45-degree field of view
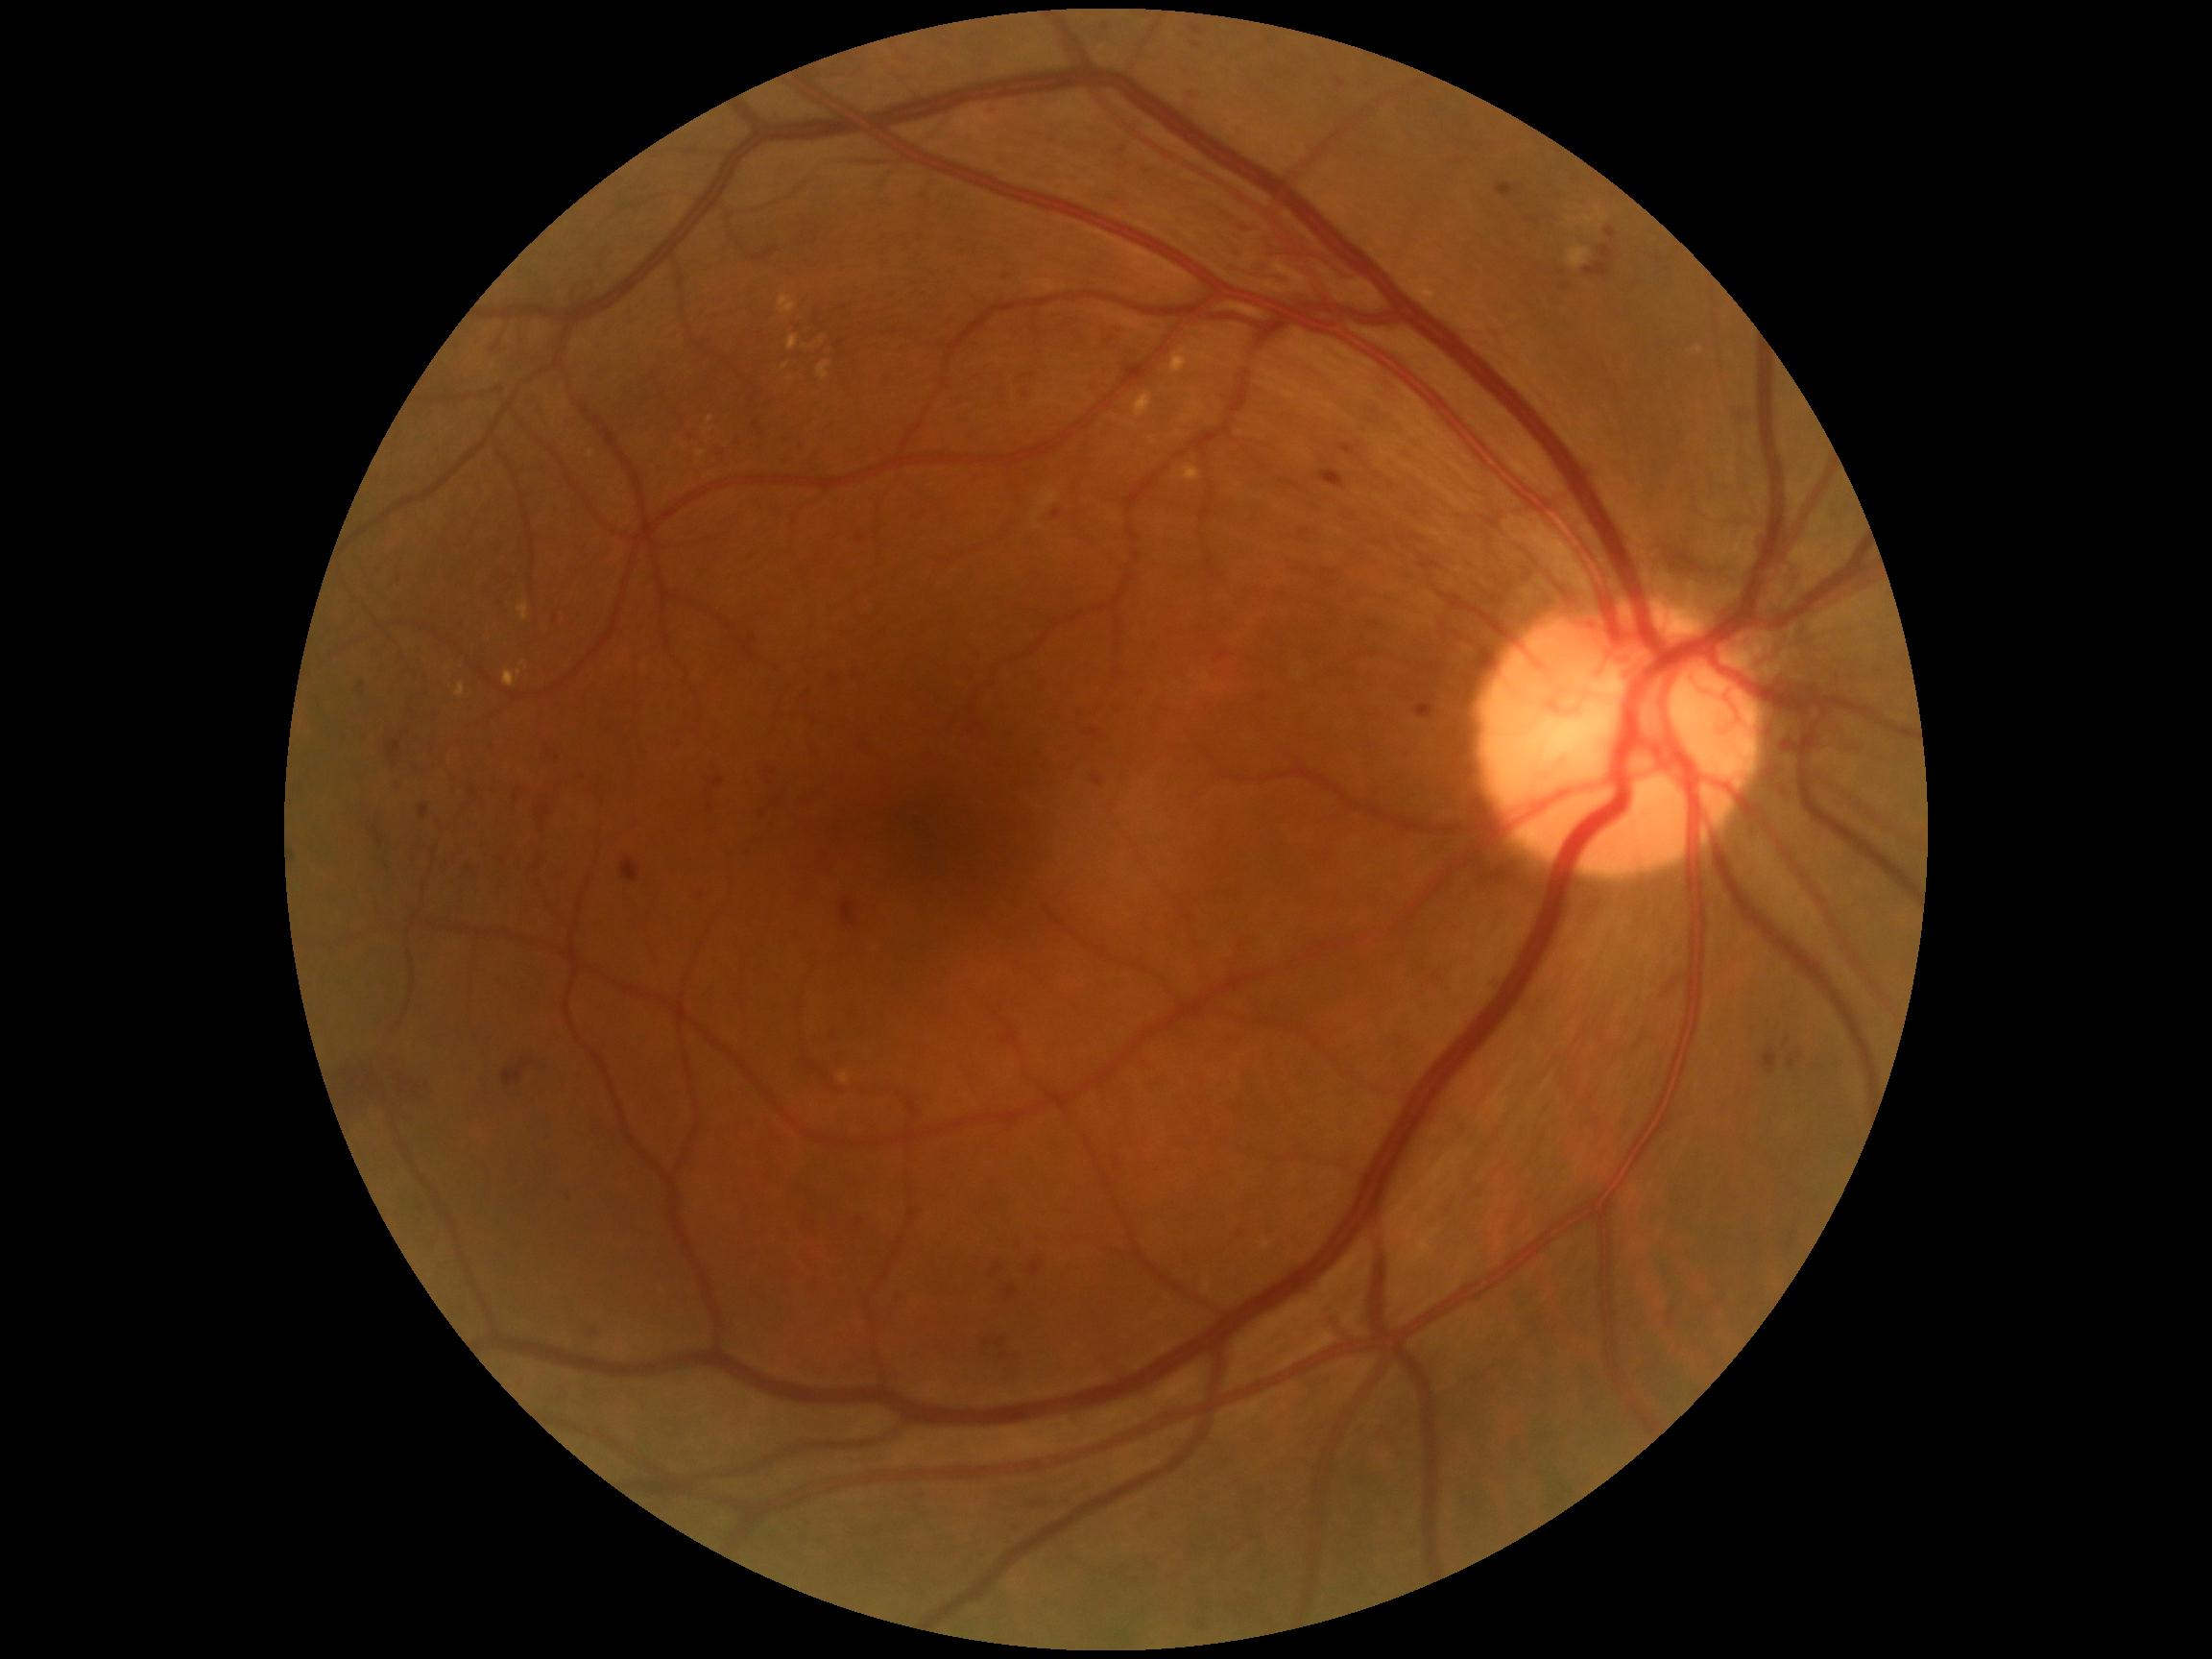

Retinopathy grade is 4/4
Lesions identified (partial list):
hard exudates (more not shown): Rect(1135, 393, 1152, 419) | Rect(1567, 247, 1591, 269) | Rect(455, 660, 464, 672) | Rect(788, 336, 799, 352) | Rect(455, 684, 465, 699) | Rect(445, 659, 450, 670) | Rect(589, 450, 595, 458) | Rect(1183, 467, 1201, 483) | Rect(504, 672, 517, 688)
Smaller hard exudates around (822; 342) | (1699; 351) | (520; 673) | (811; 347)
soft exudates: not present
hemorrhages (more not shown): Rect(1605, 227, 1617, 240) | Rect(1763, 1049, 1777, 1075) | Rect(780, 431, 791, 441) | Rect(1099, 324, 1125, 354) | Rect(987, 1260, 1001, 1281) | Rect(388, 741, 402, 768) | Rect(536, 781, 552, 825) | Rect(1032, 1264, 1040, 1276) | Rect(1008, 1288, 1018, 1298) | Rect(999, 1353, 1011, 1361) | Rect(330, 1057, 431, 1120) | Rect(1190, 26, 1204, 36) | Rect(1185, 85, 1204, 97) | Rect(584, 1326, 600, 1338) | Rect(979, 1337, 994, 1347) | Rect(369, 826, 385, 847) | Rect(1190, 42, 1202, 49) | Rect(622, 860, 641, 884)
Smaller hemorrhages around (1565; 288)
microaneurysms (more not shown): Rect(1093, 777, 1104, 787) | Rect(1409, 703, 1429, 717) | Rect(891, 1297, 901, 1307) | Rect(783, 455, 791, 462) | Rect(1233, 1234, 1240, 1242) | Rect(714, 778, 725, 787) | Rect(1657, 256, 1663, 264) | Rect(545, 751, 557, 763) | Rect(854, 1214, 858, 1229) | Rect(1260, 694, 1268, 703) | Rect(1340, 444, 1357, 455) | Rect(421, 805, 430, 820)
Smaller microaneurysms around (844; 308)